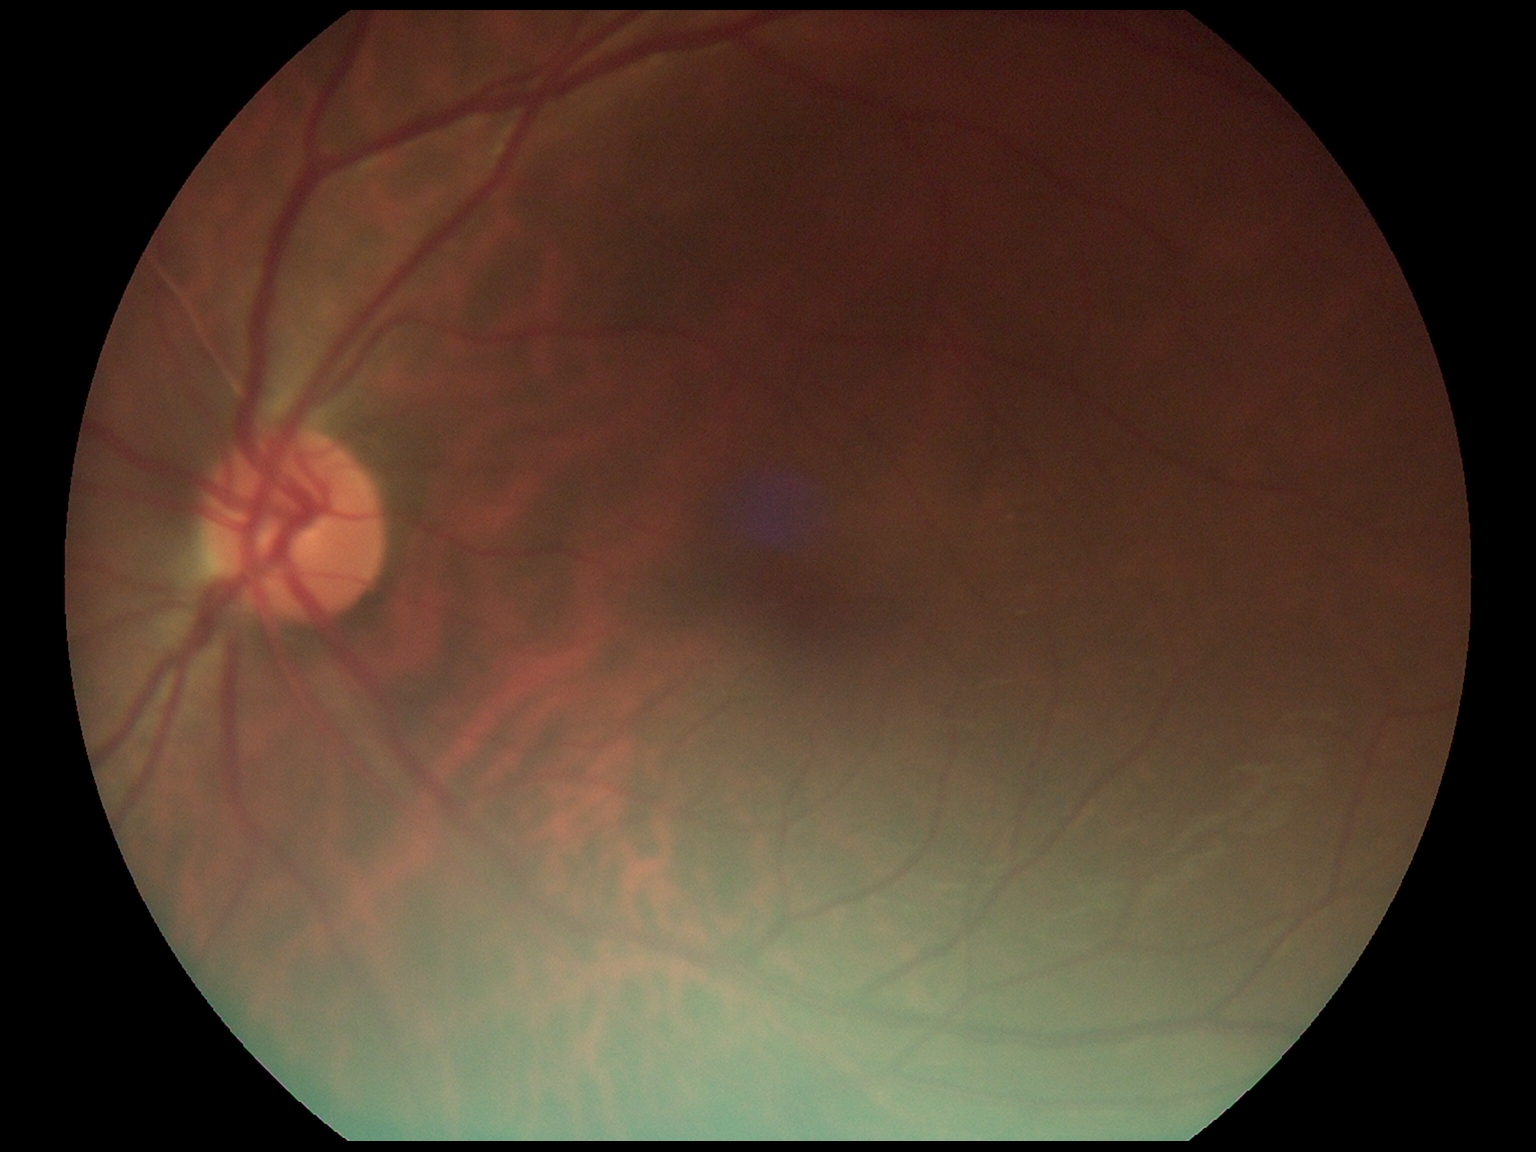 dr_grade: 0/4
dr_impression: no apparent DR